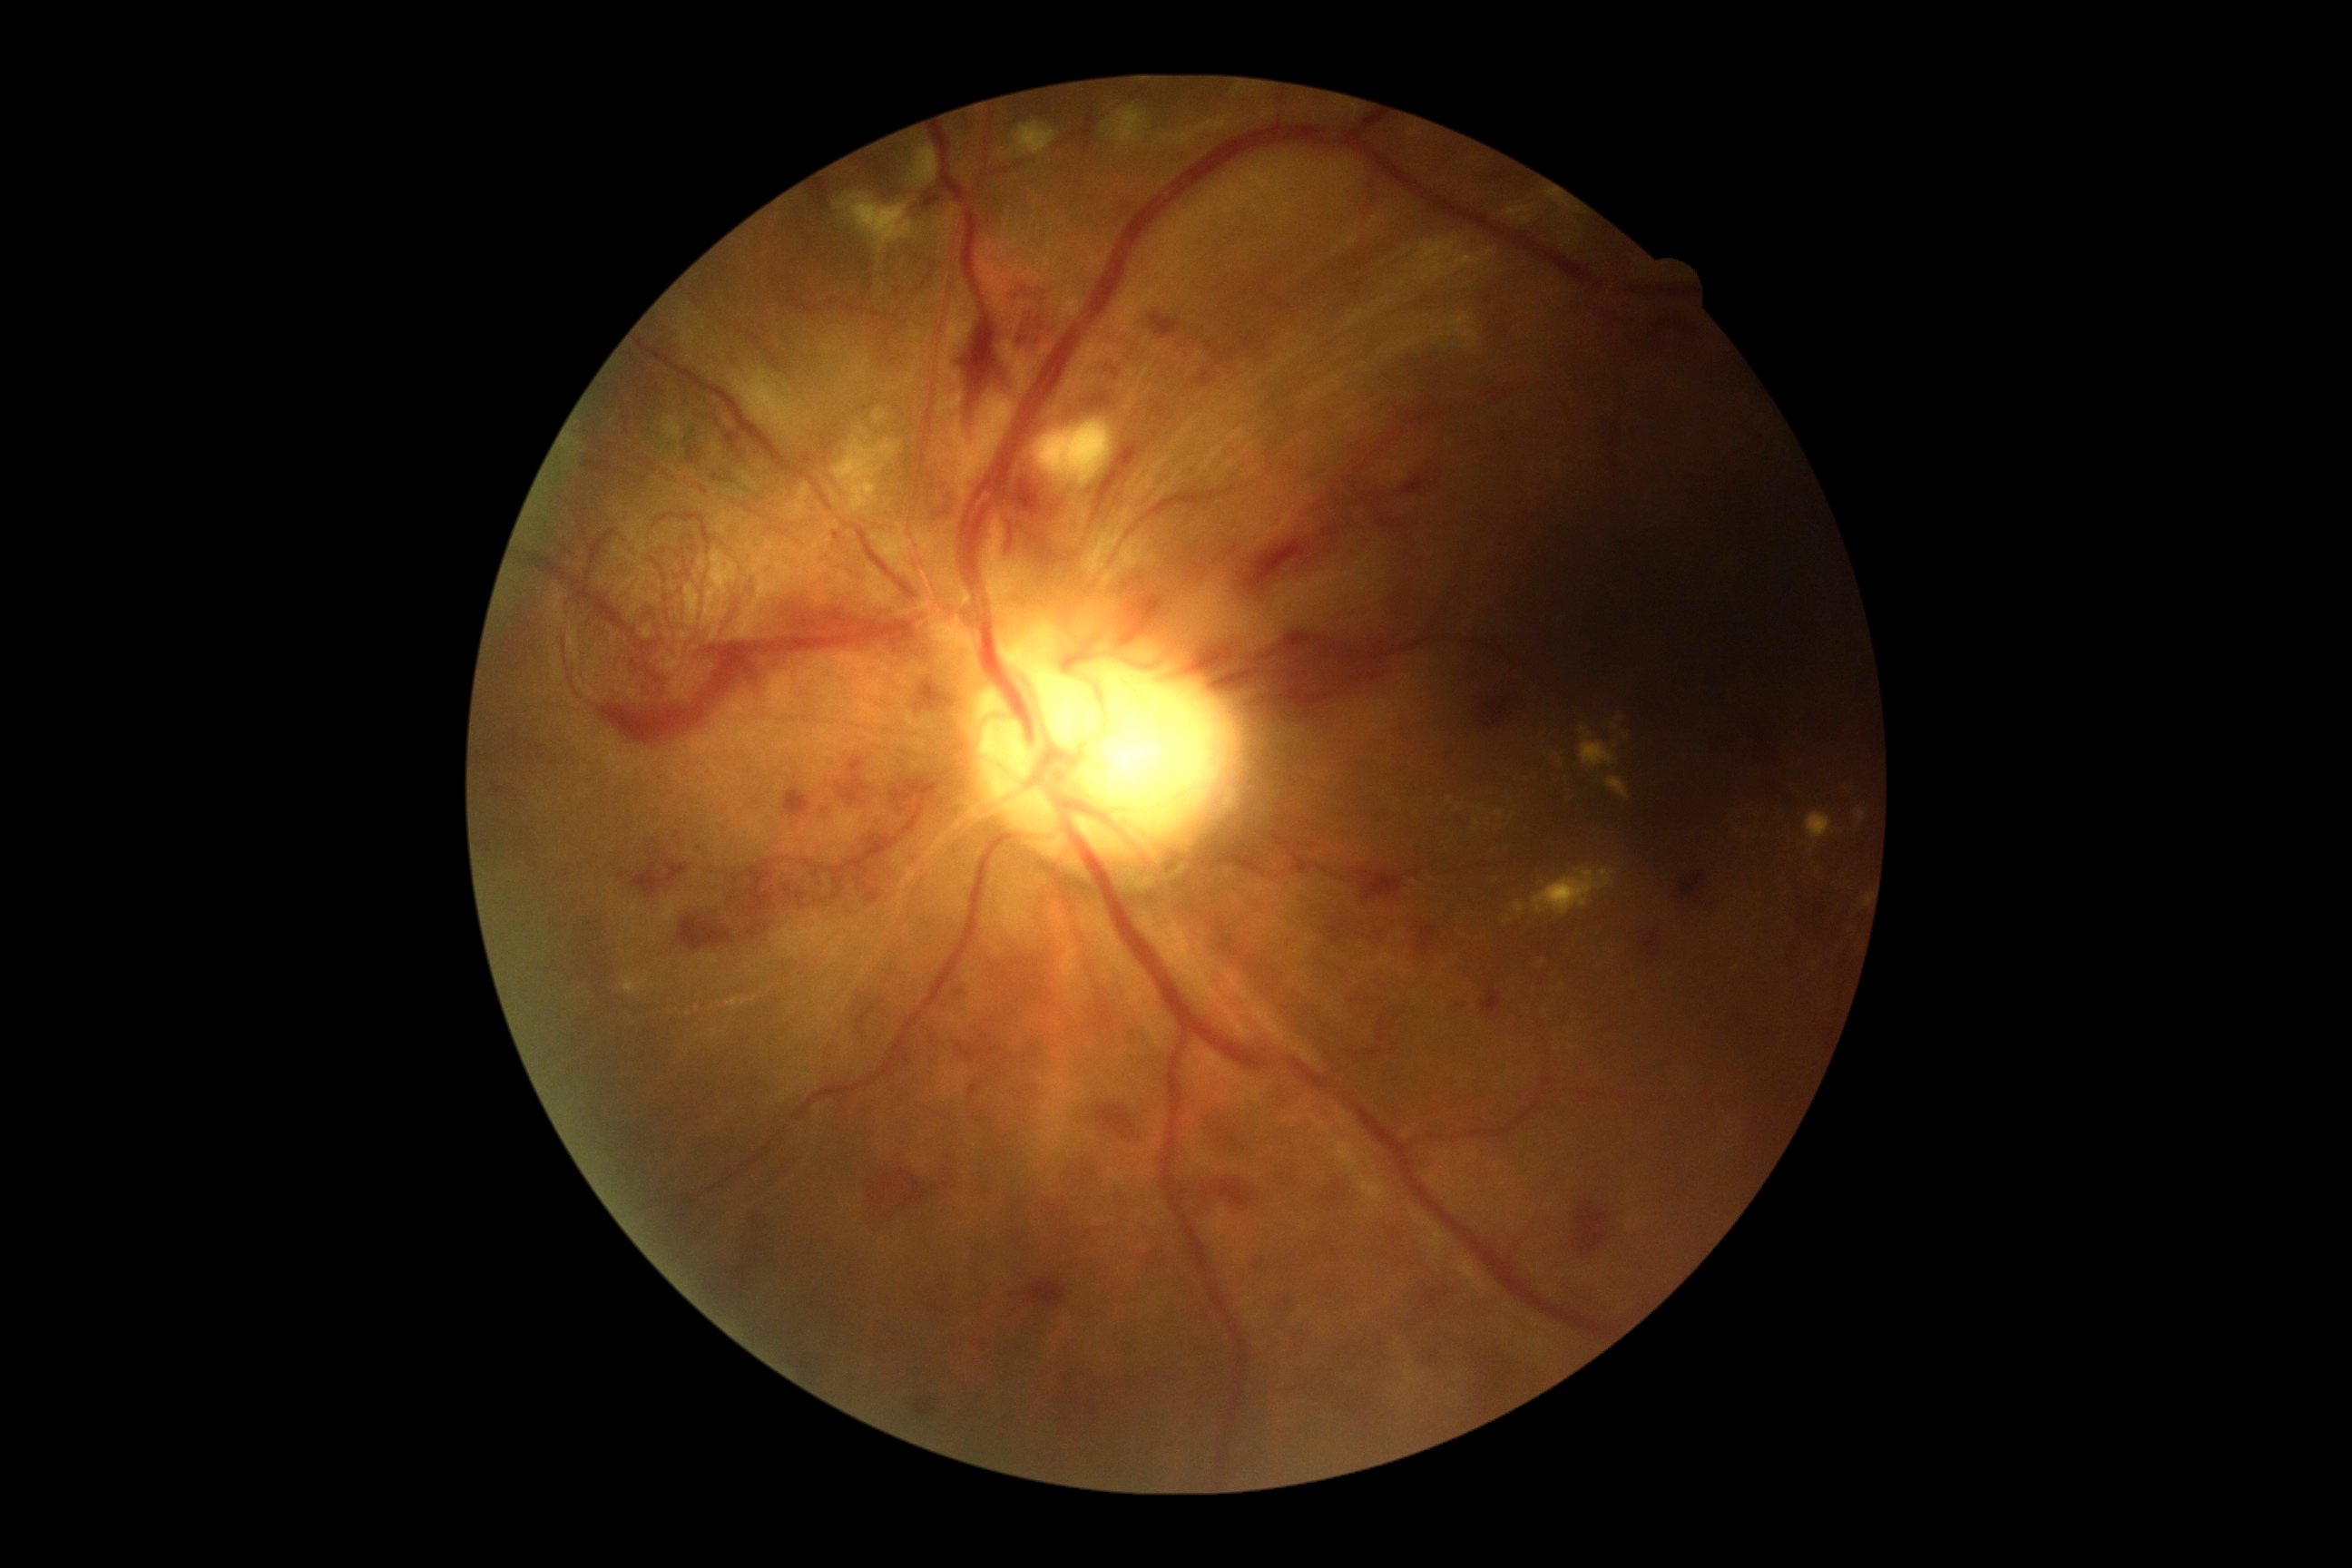 DR stage is PDR (grade 4).